Woman. Disc-centered field. 30° FOV. Intraocular pressure: 14 mmHg. Refractive error: +1.25 -1.25 x 60.
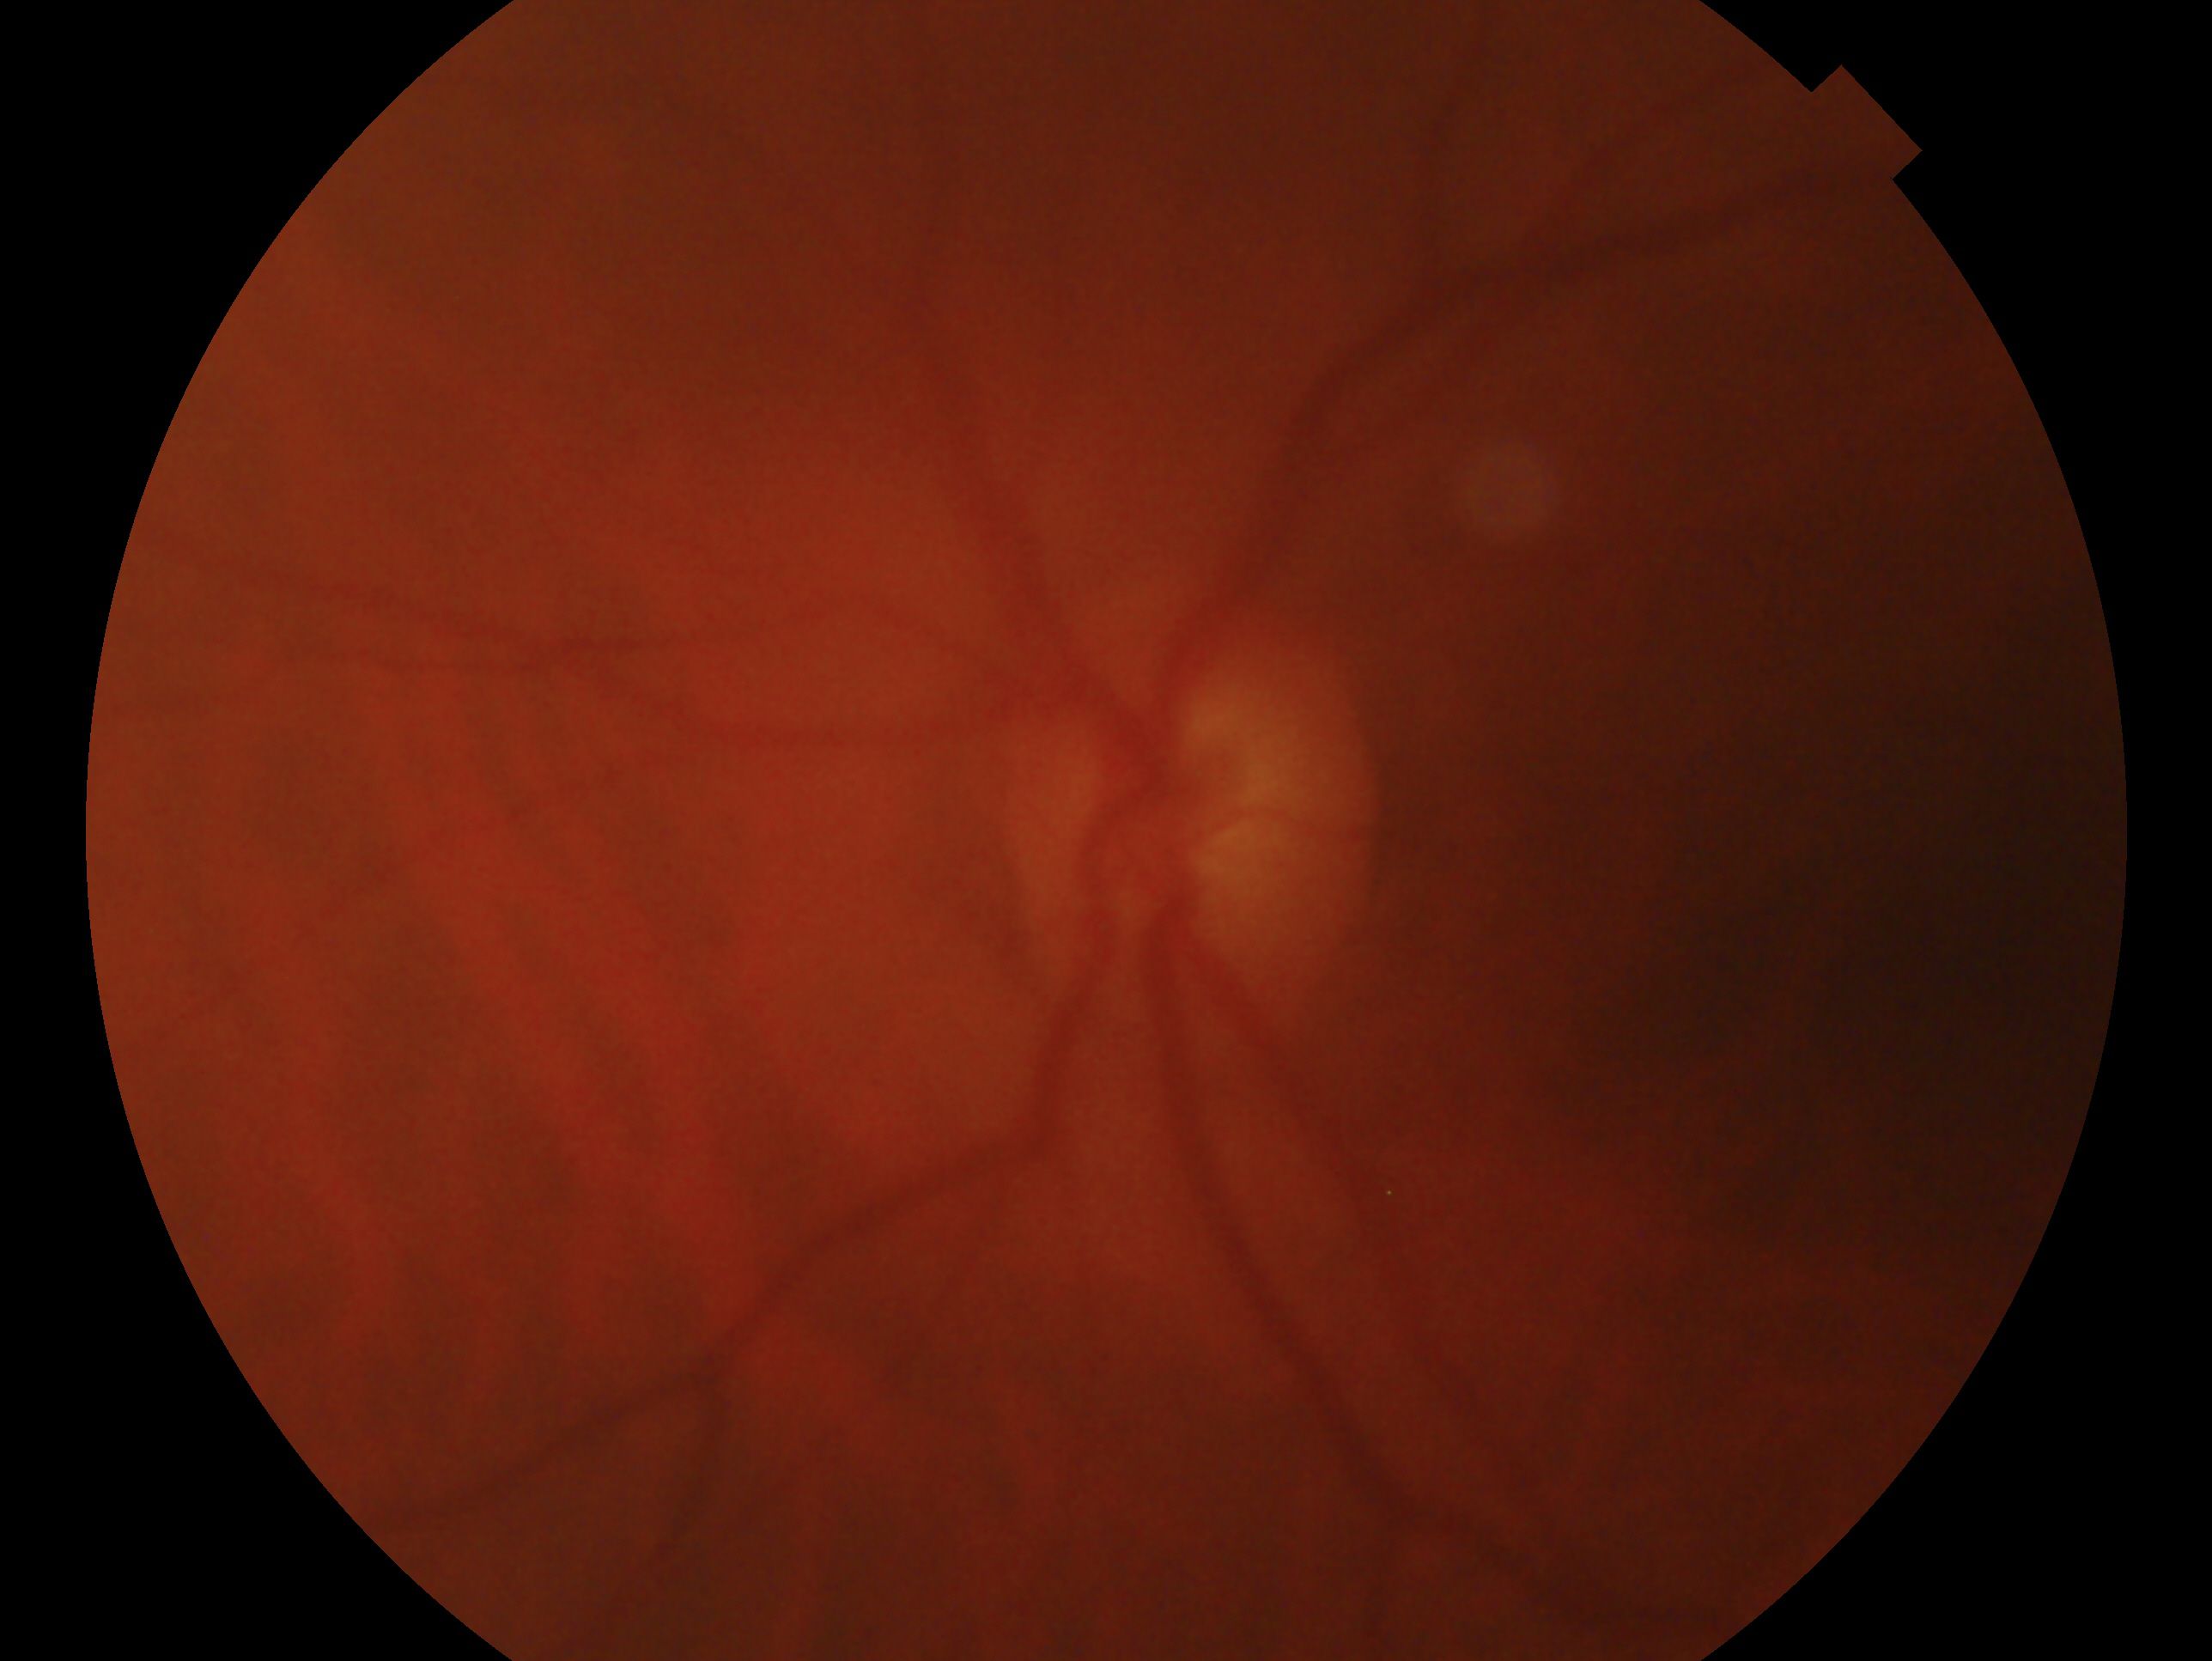

The image shows the left eye.
Assessment: glaucoma — clinically confirmed glaucoma with characteristic optic nerve damage.